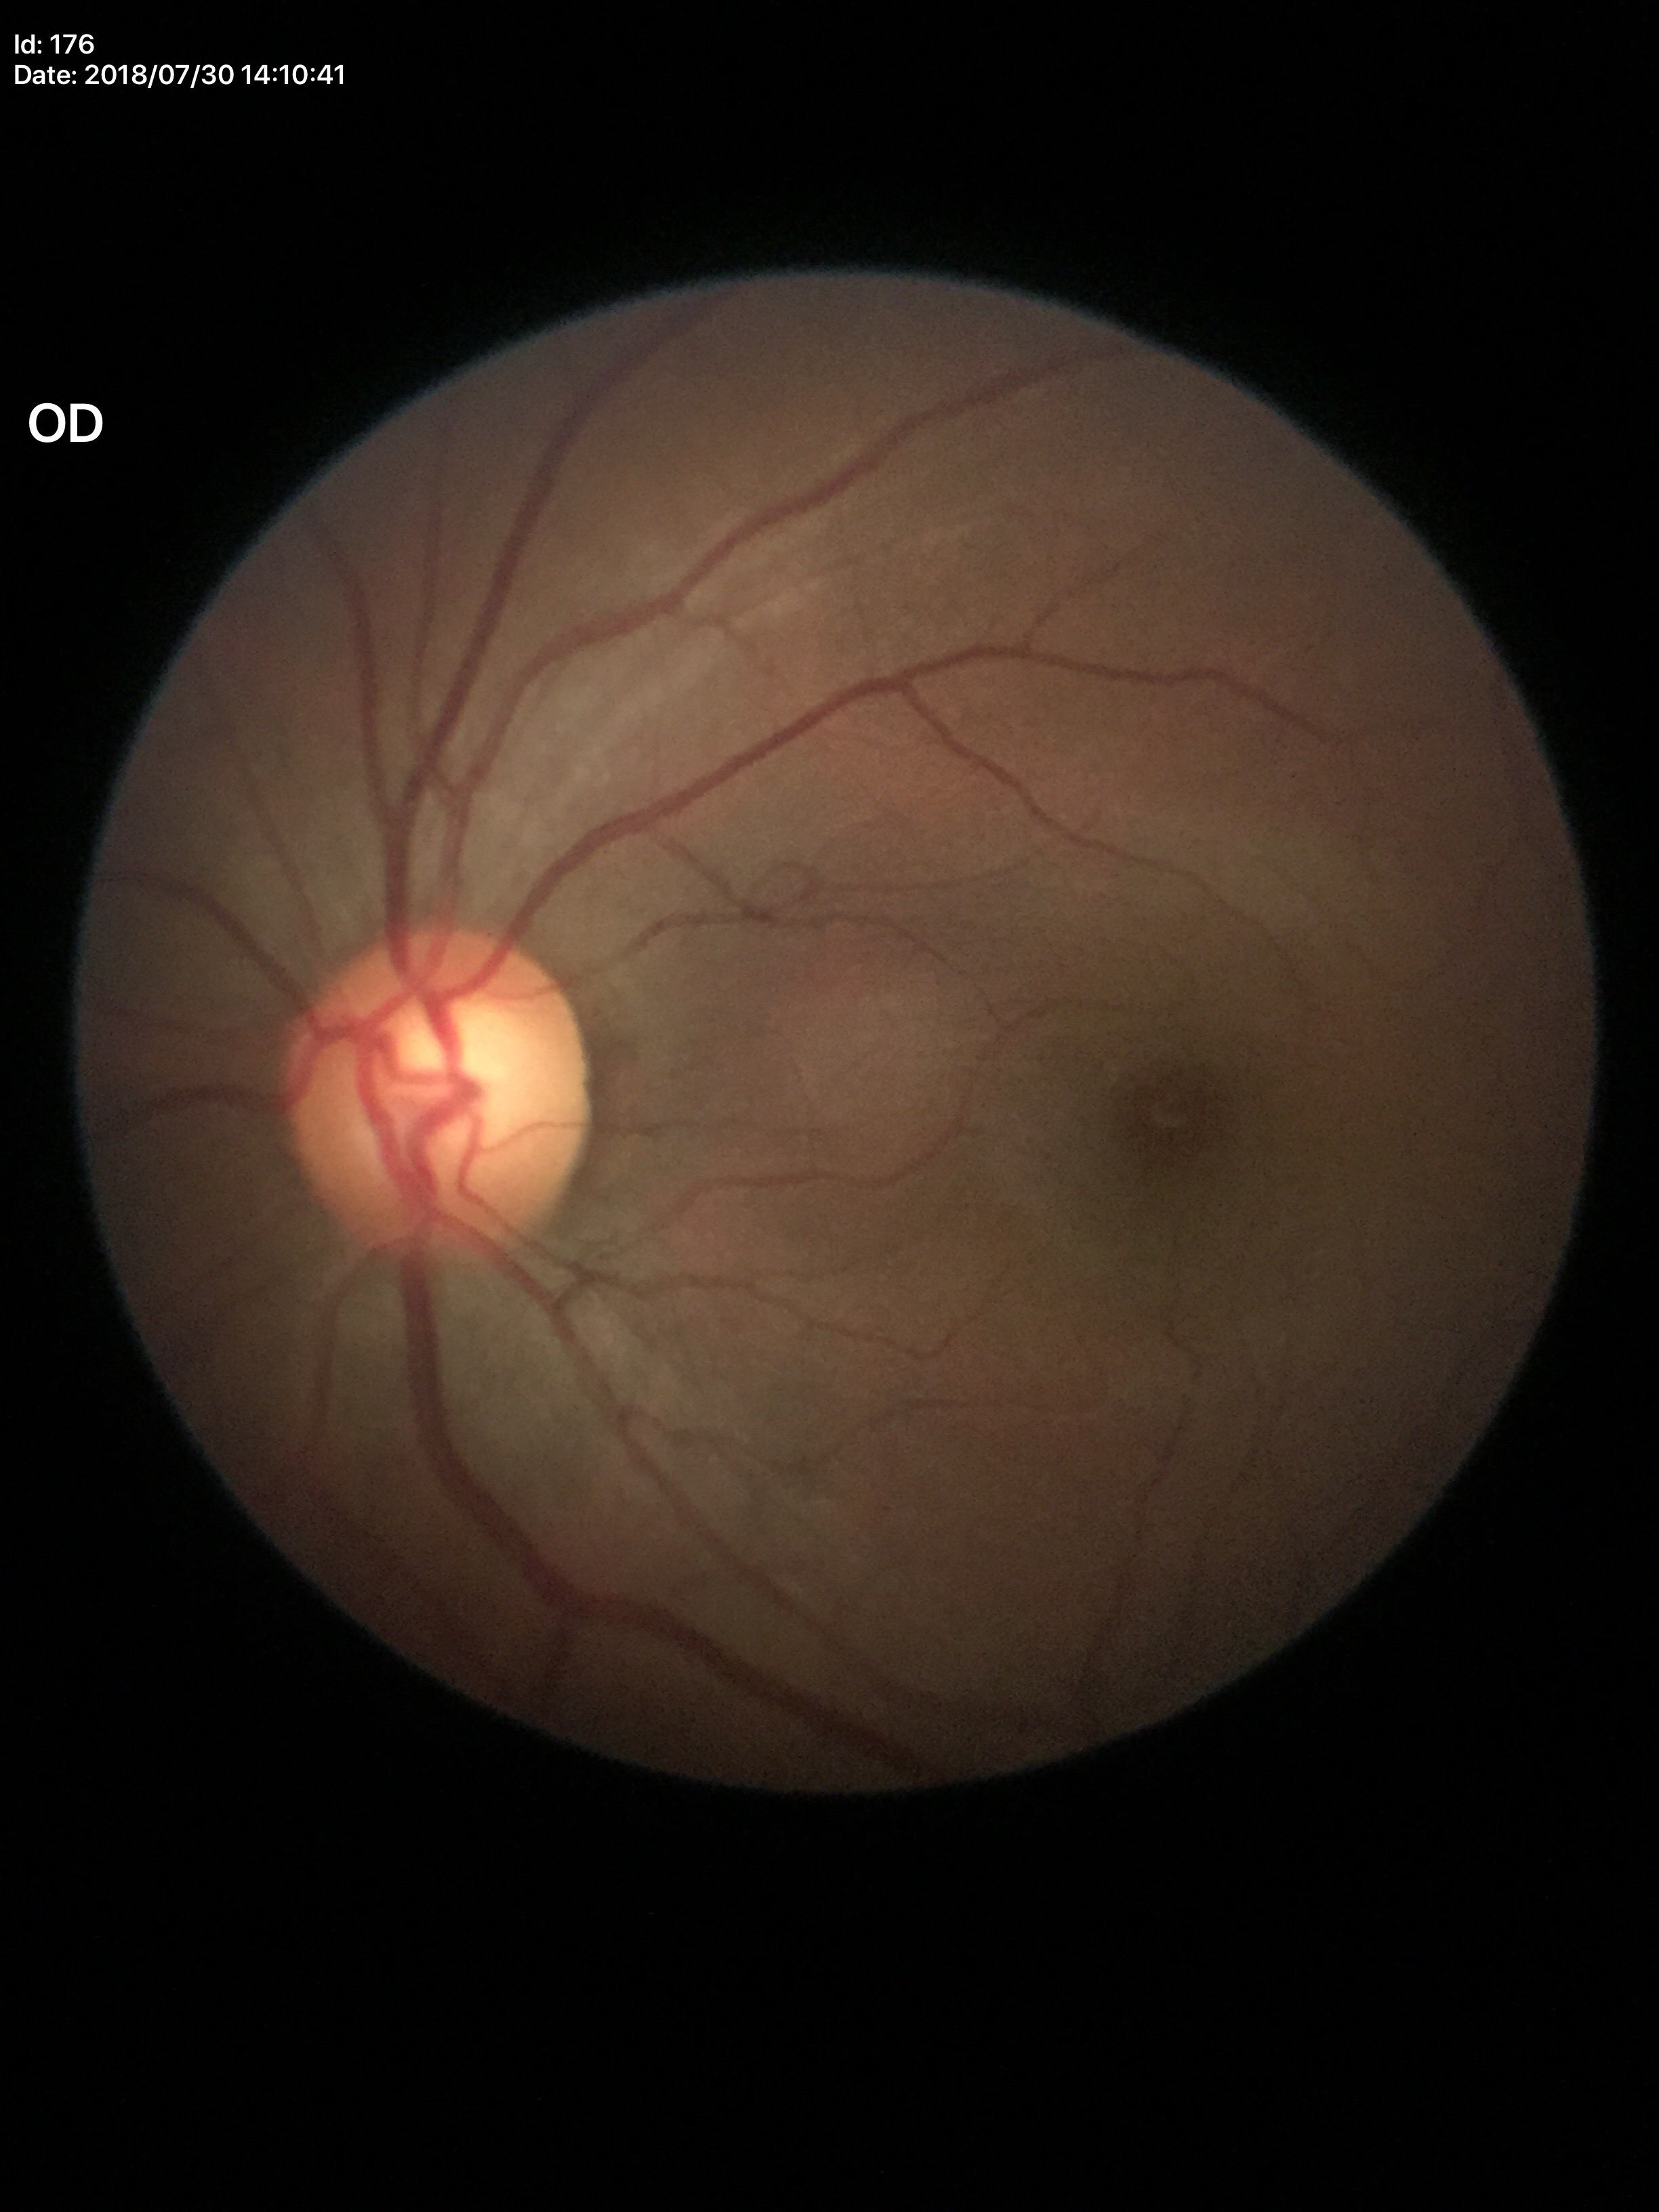
Annotations:
* Glaucoma impression · negative (2/5 graders called glaucoma suspect)
* vertical cup-to-disc ratio (VCDR) · 0.60